CFP.
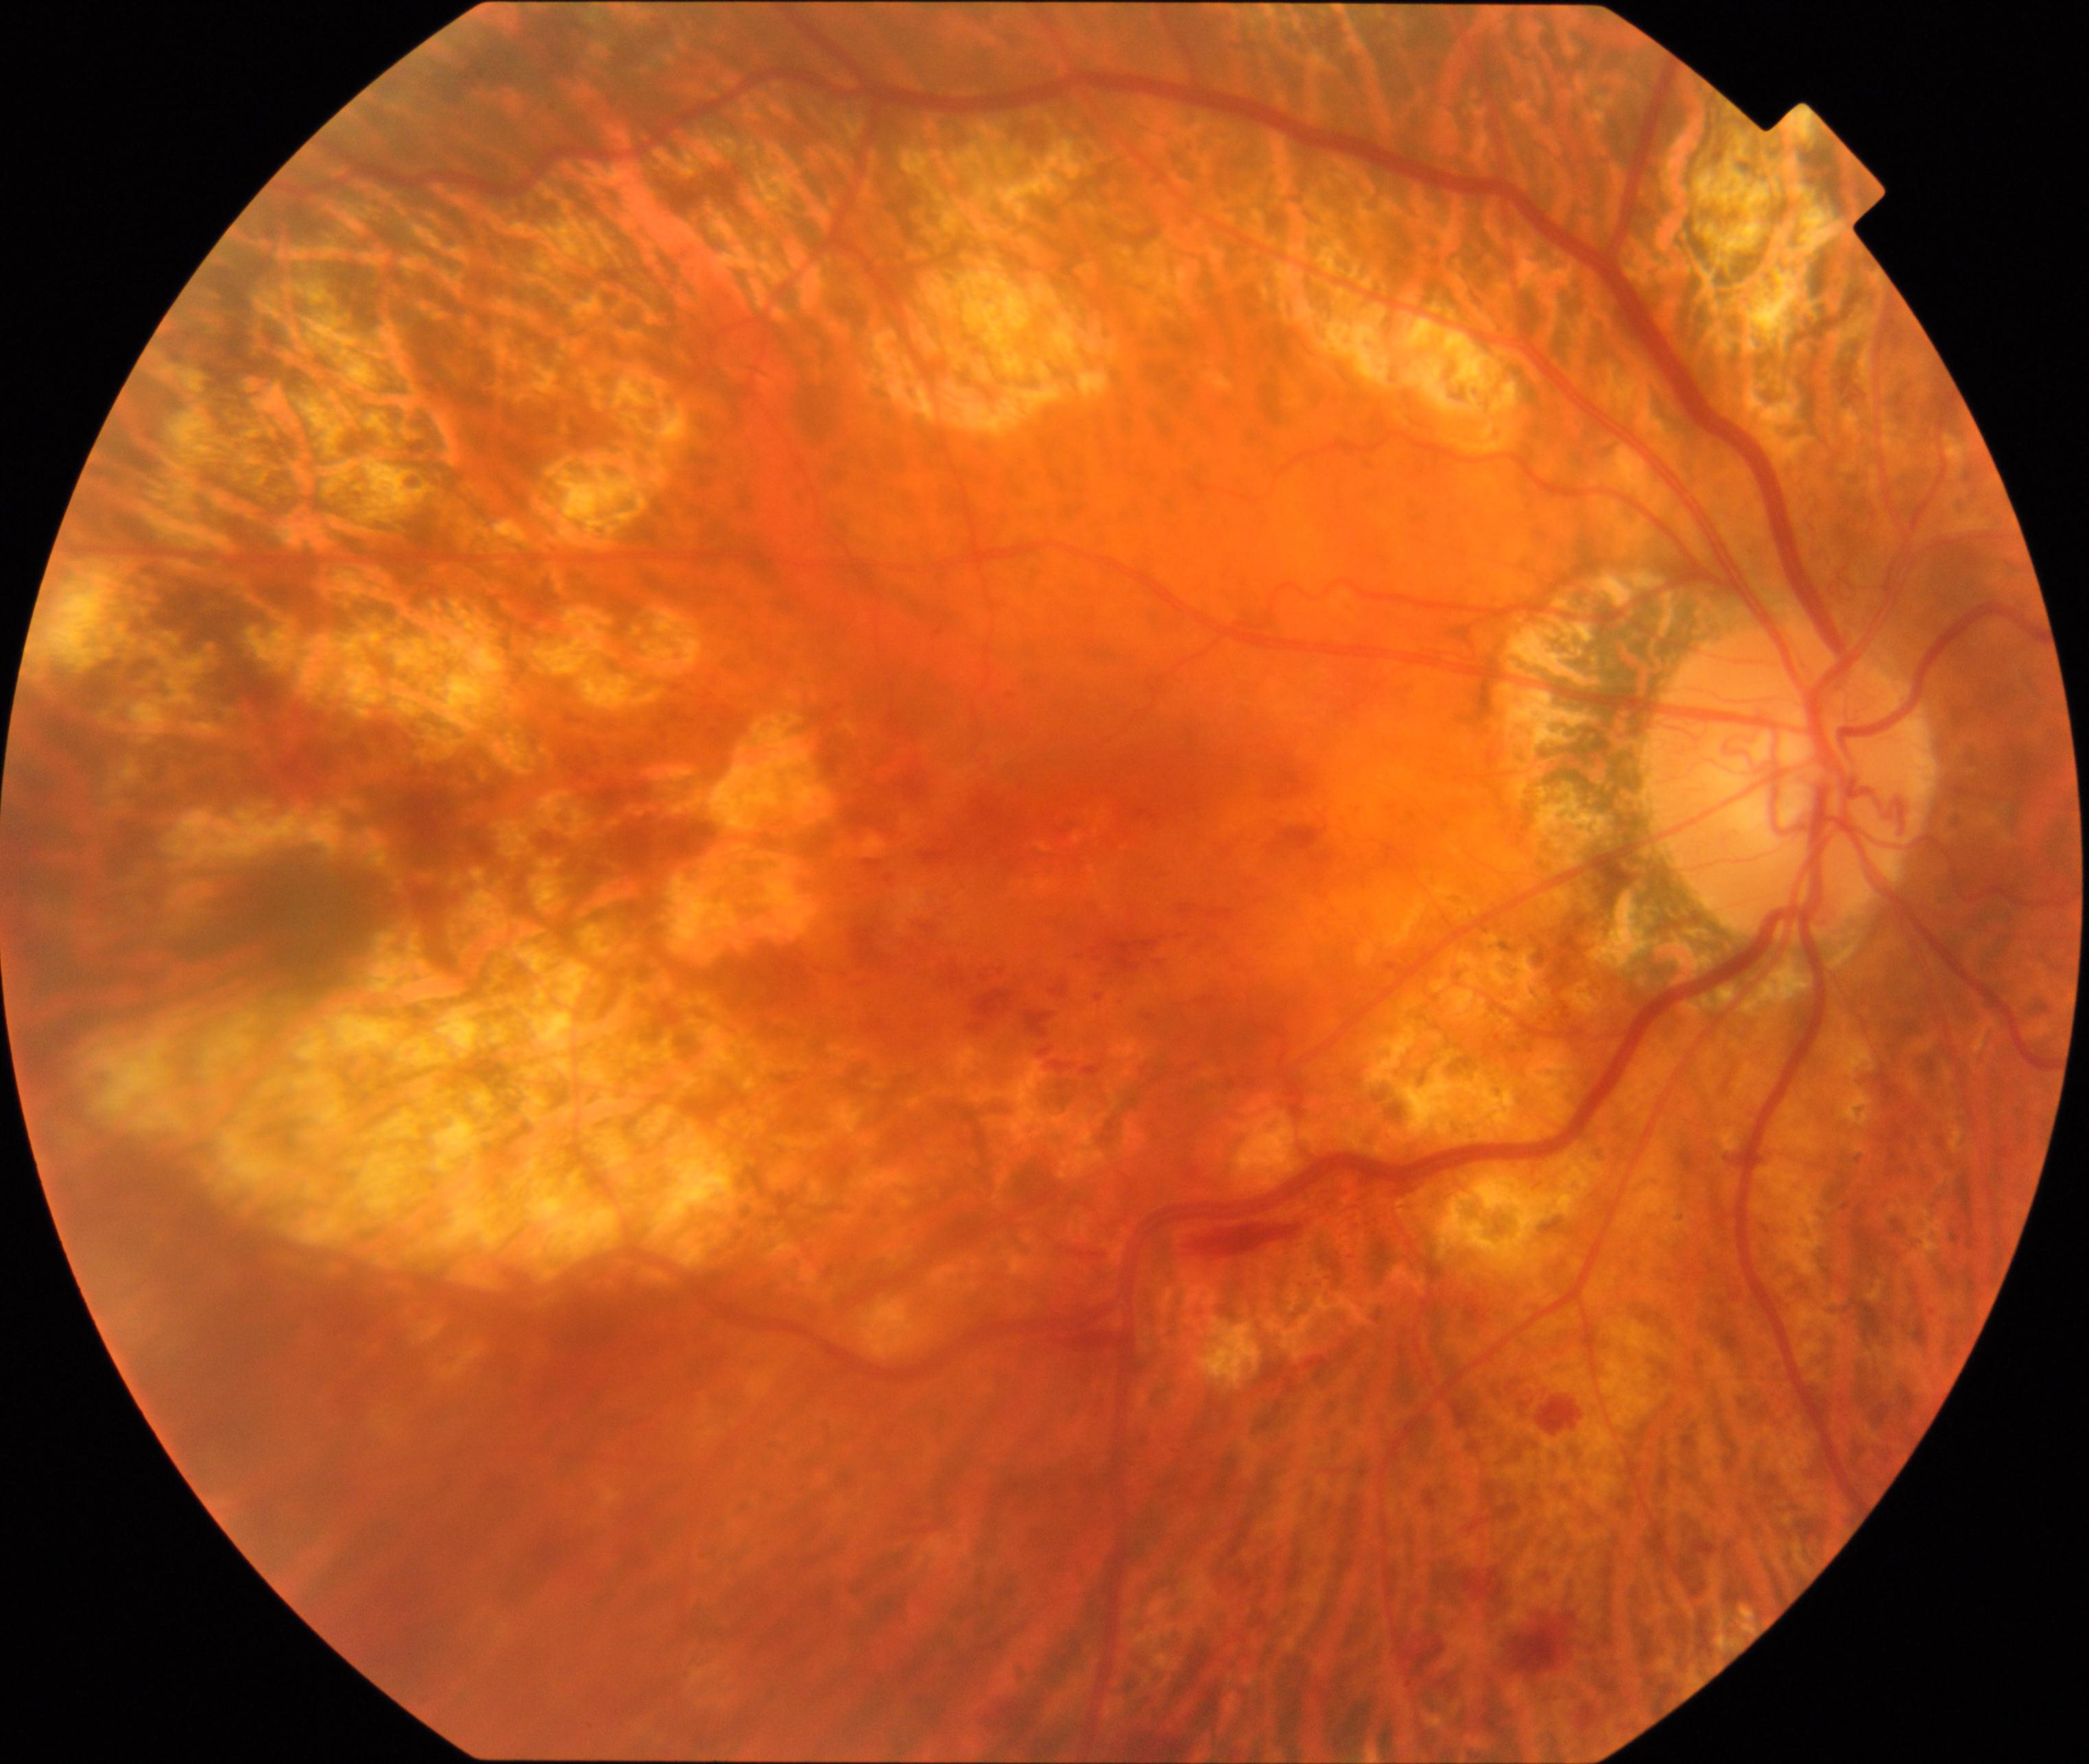 There is evidence of pathological myopia.